Acquired with a Topcon TRC-NW8; 50-degree field of view
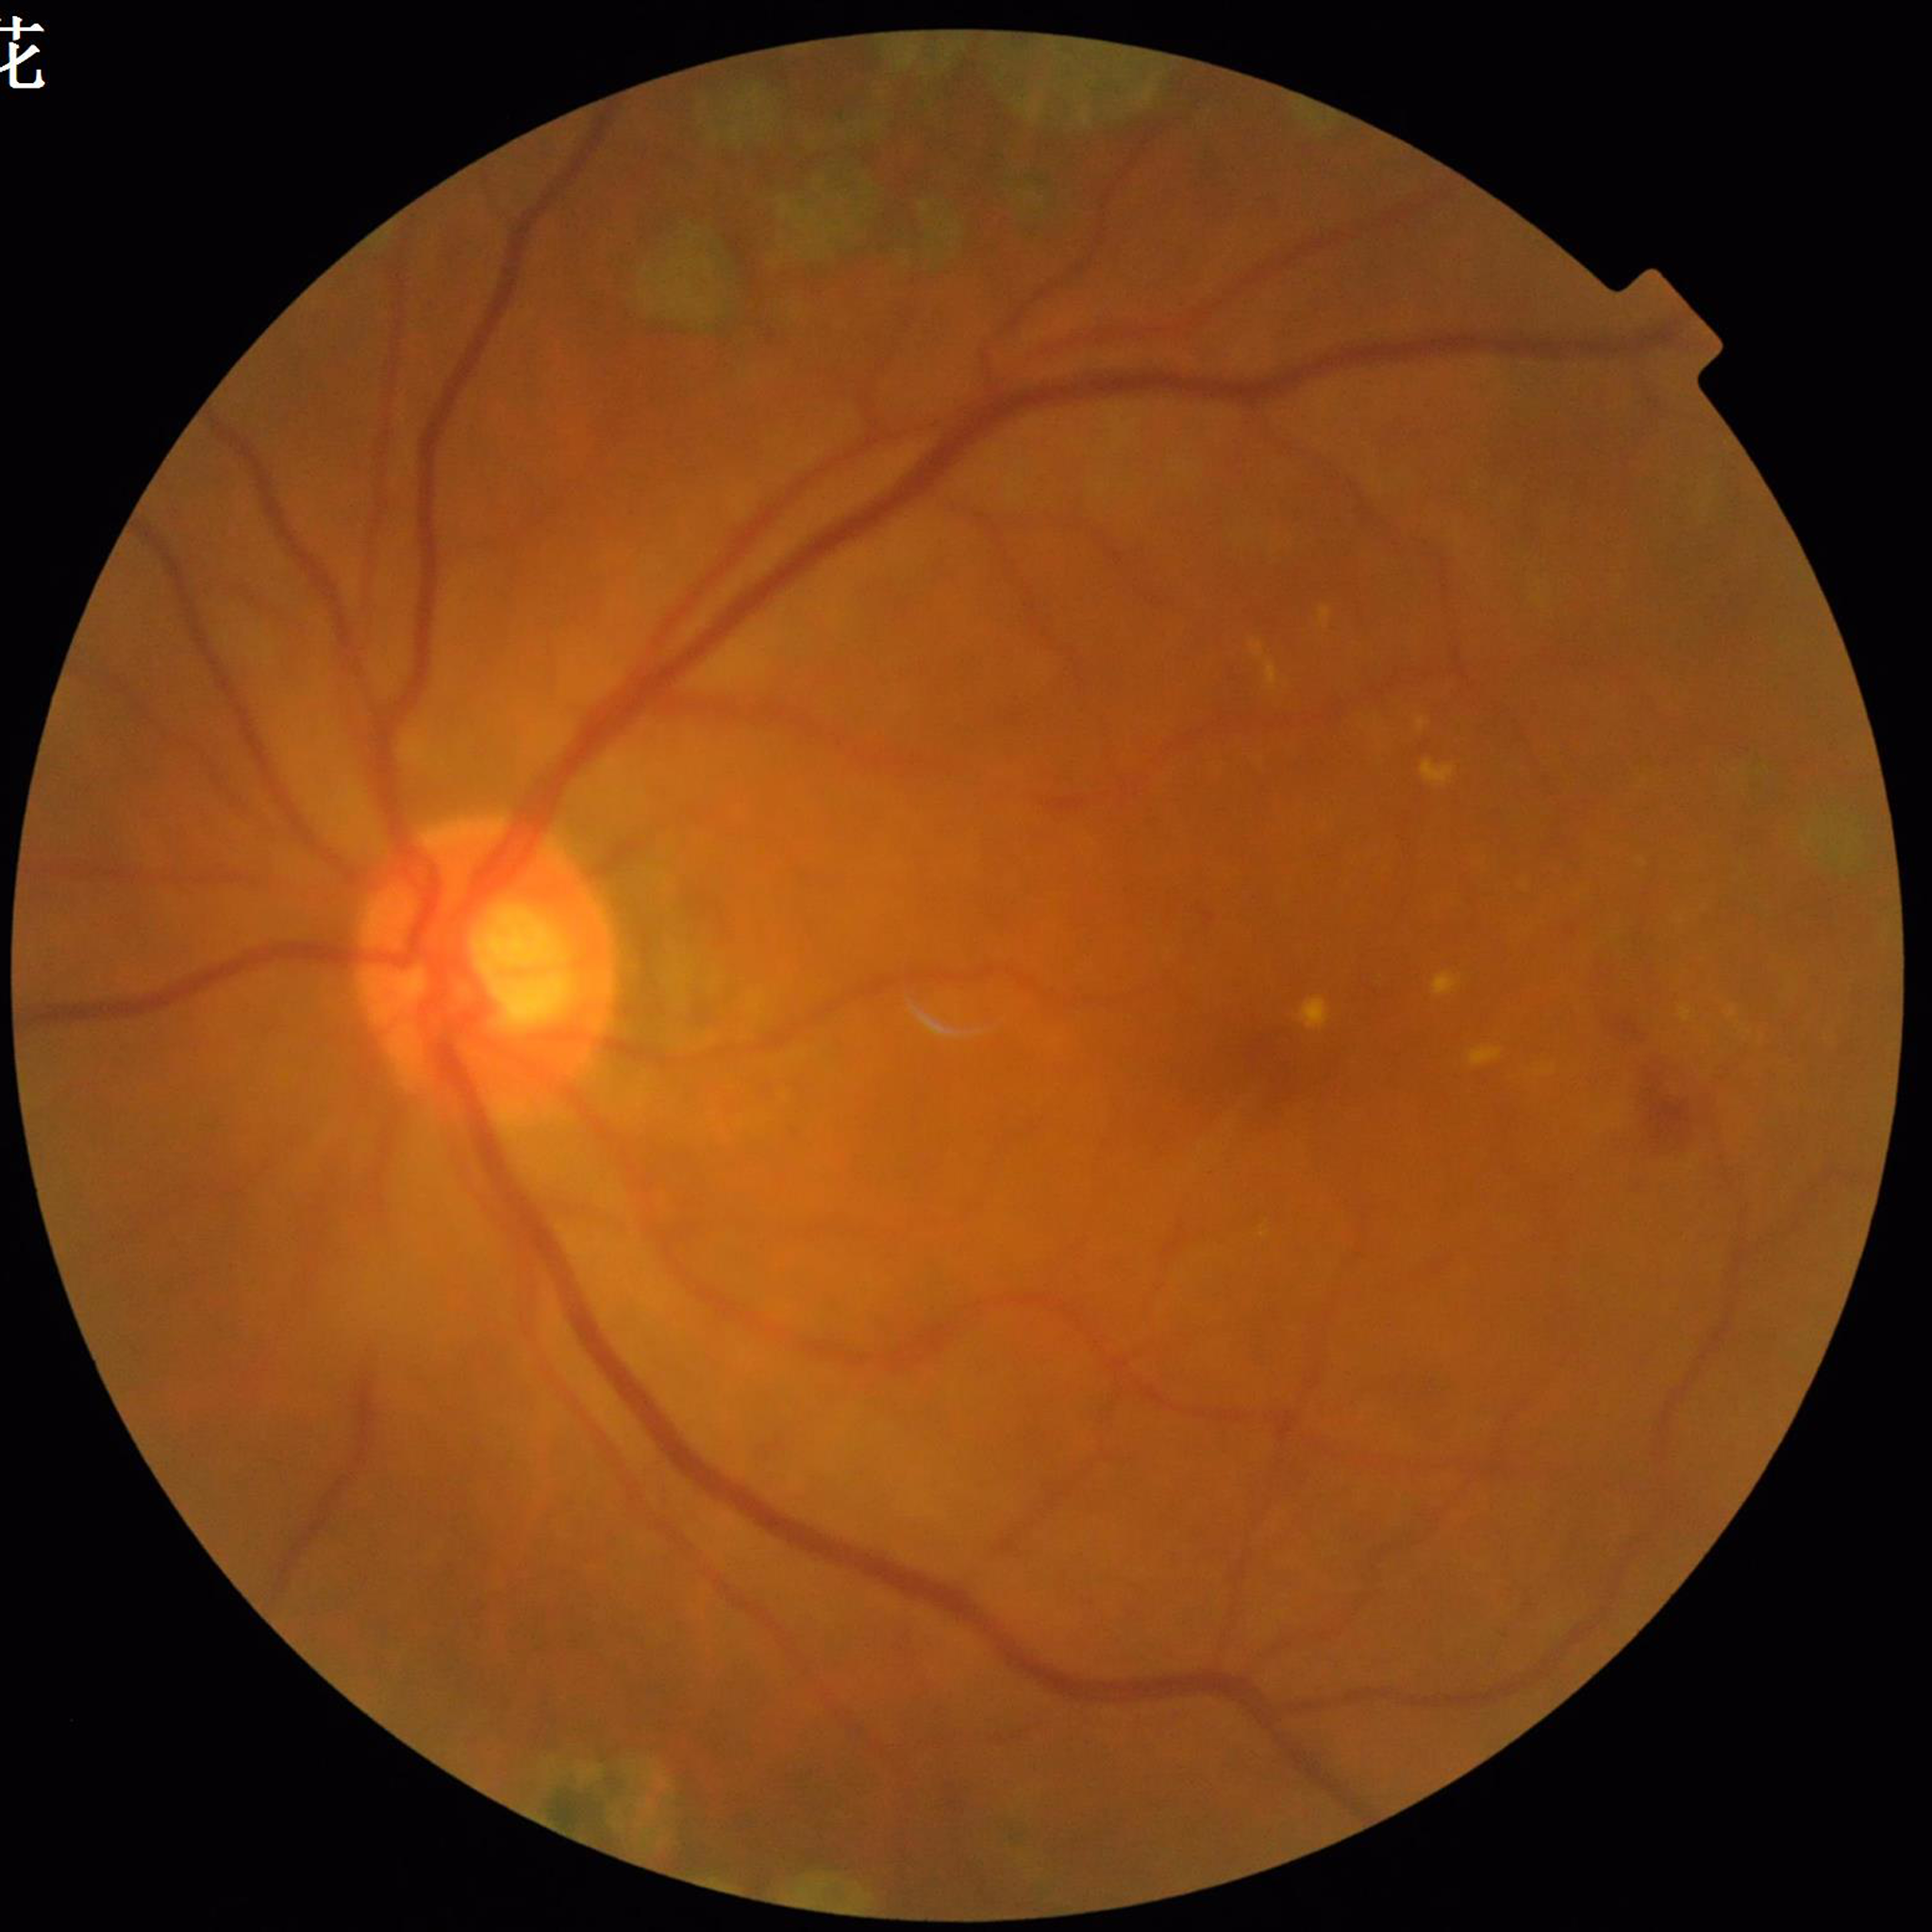
Quality assessment: good | Diagnosis: diabetic retinopathy (DR).